2352x1568:
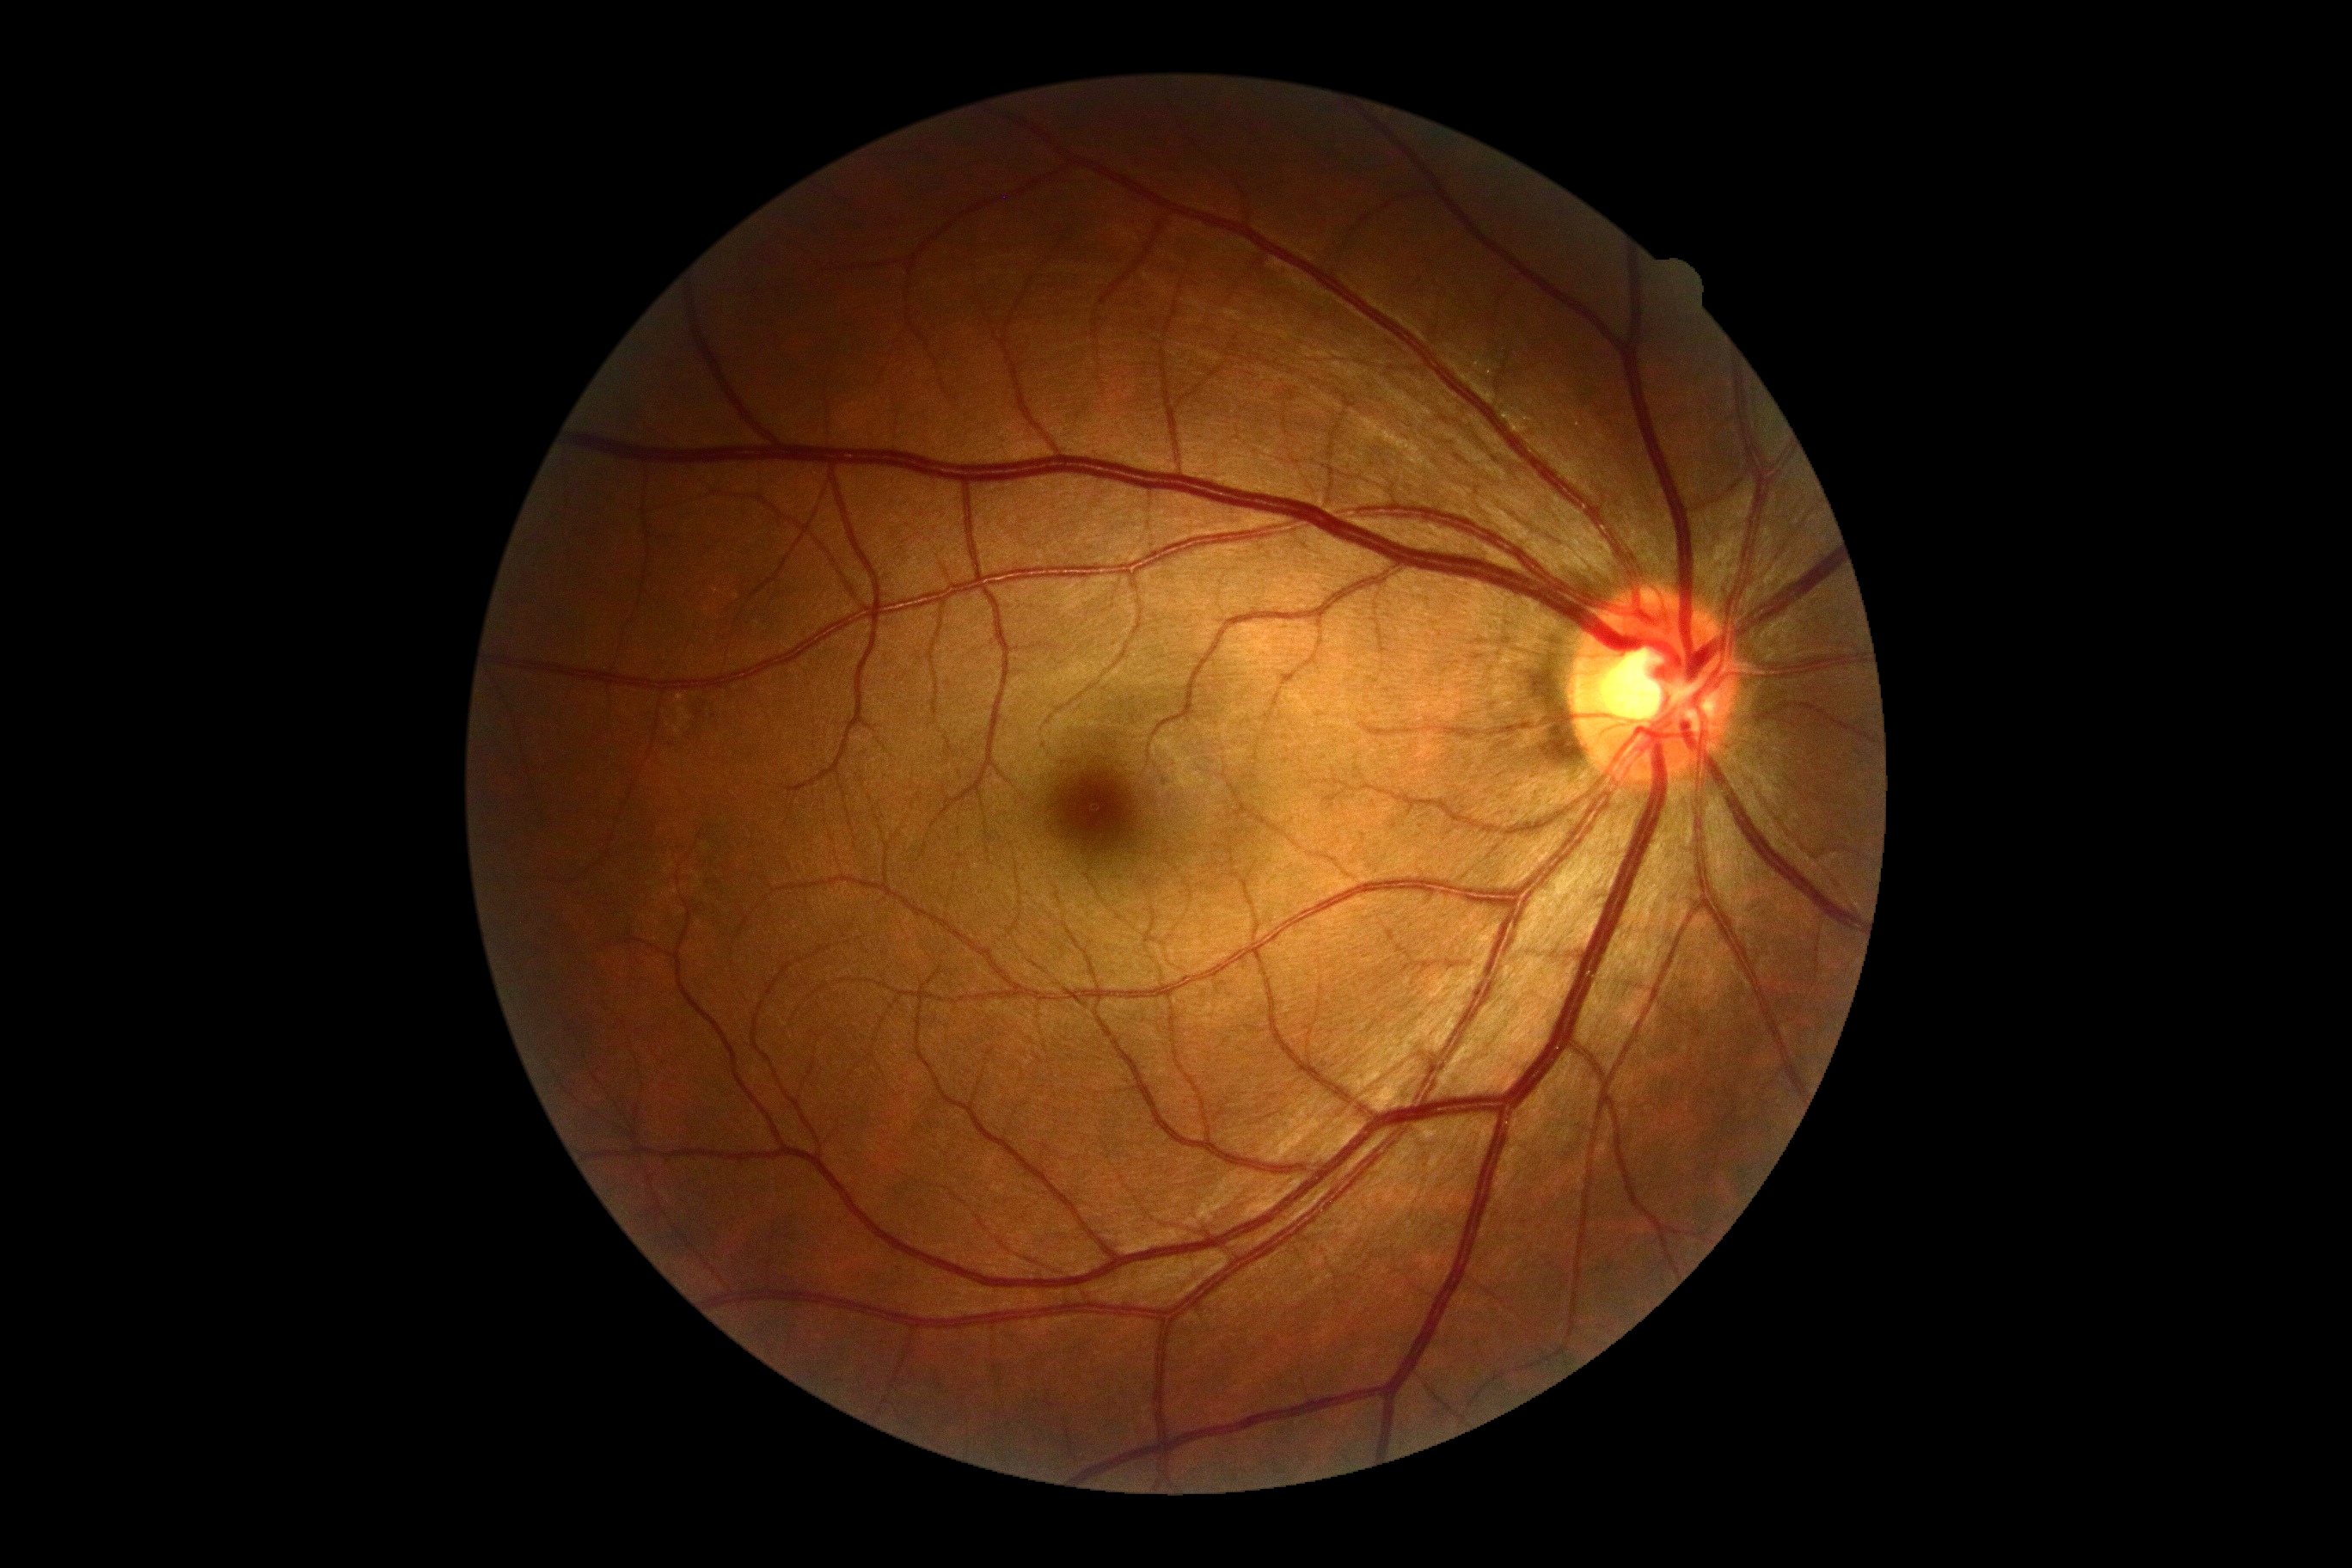 DR stage: no apparent retinopathy (grade 0); DR impression: no apparent DR.